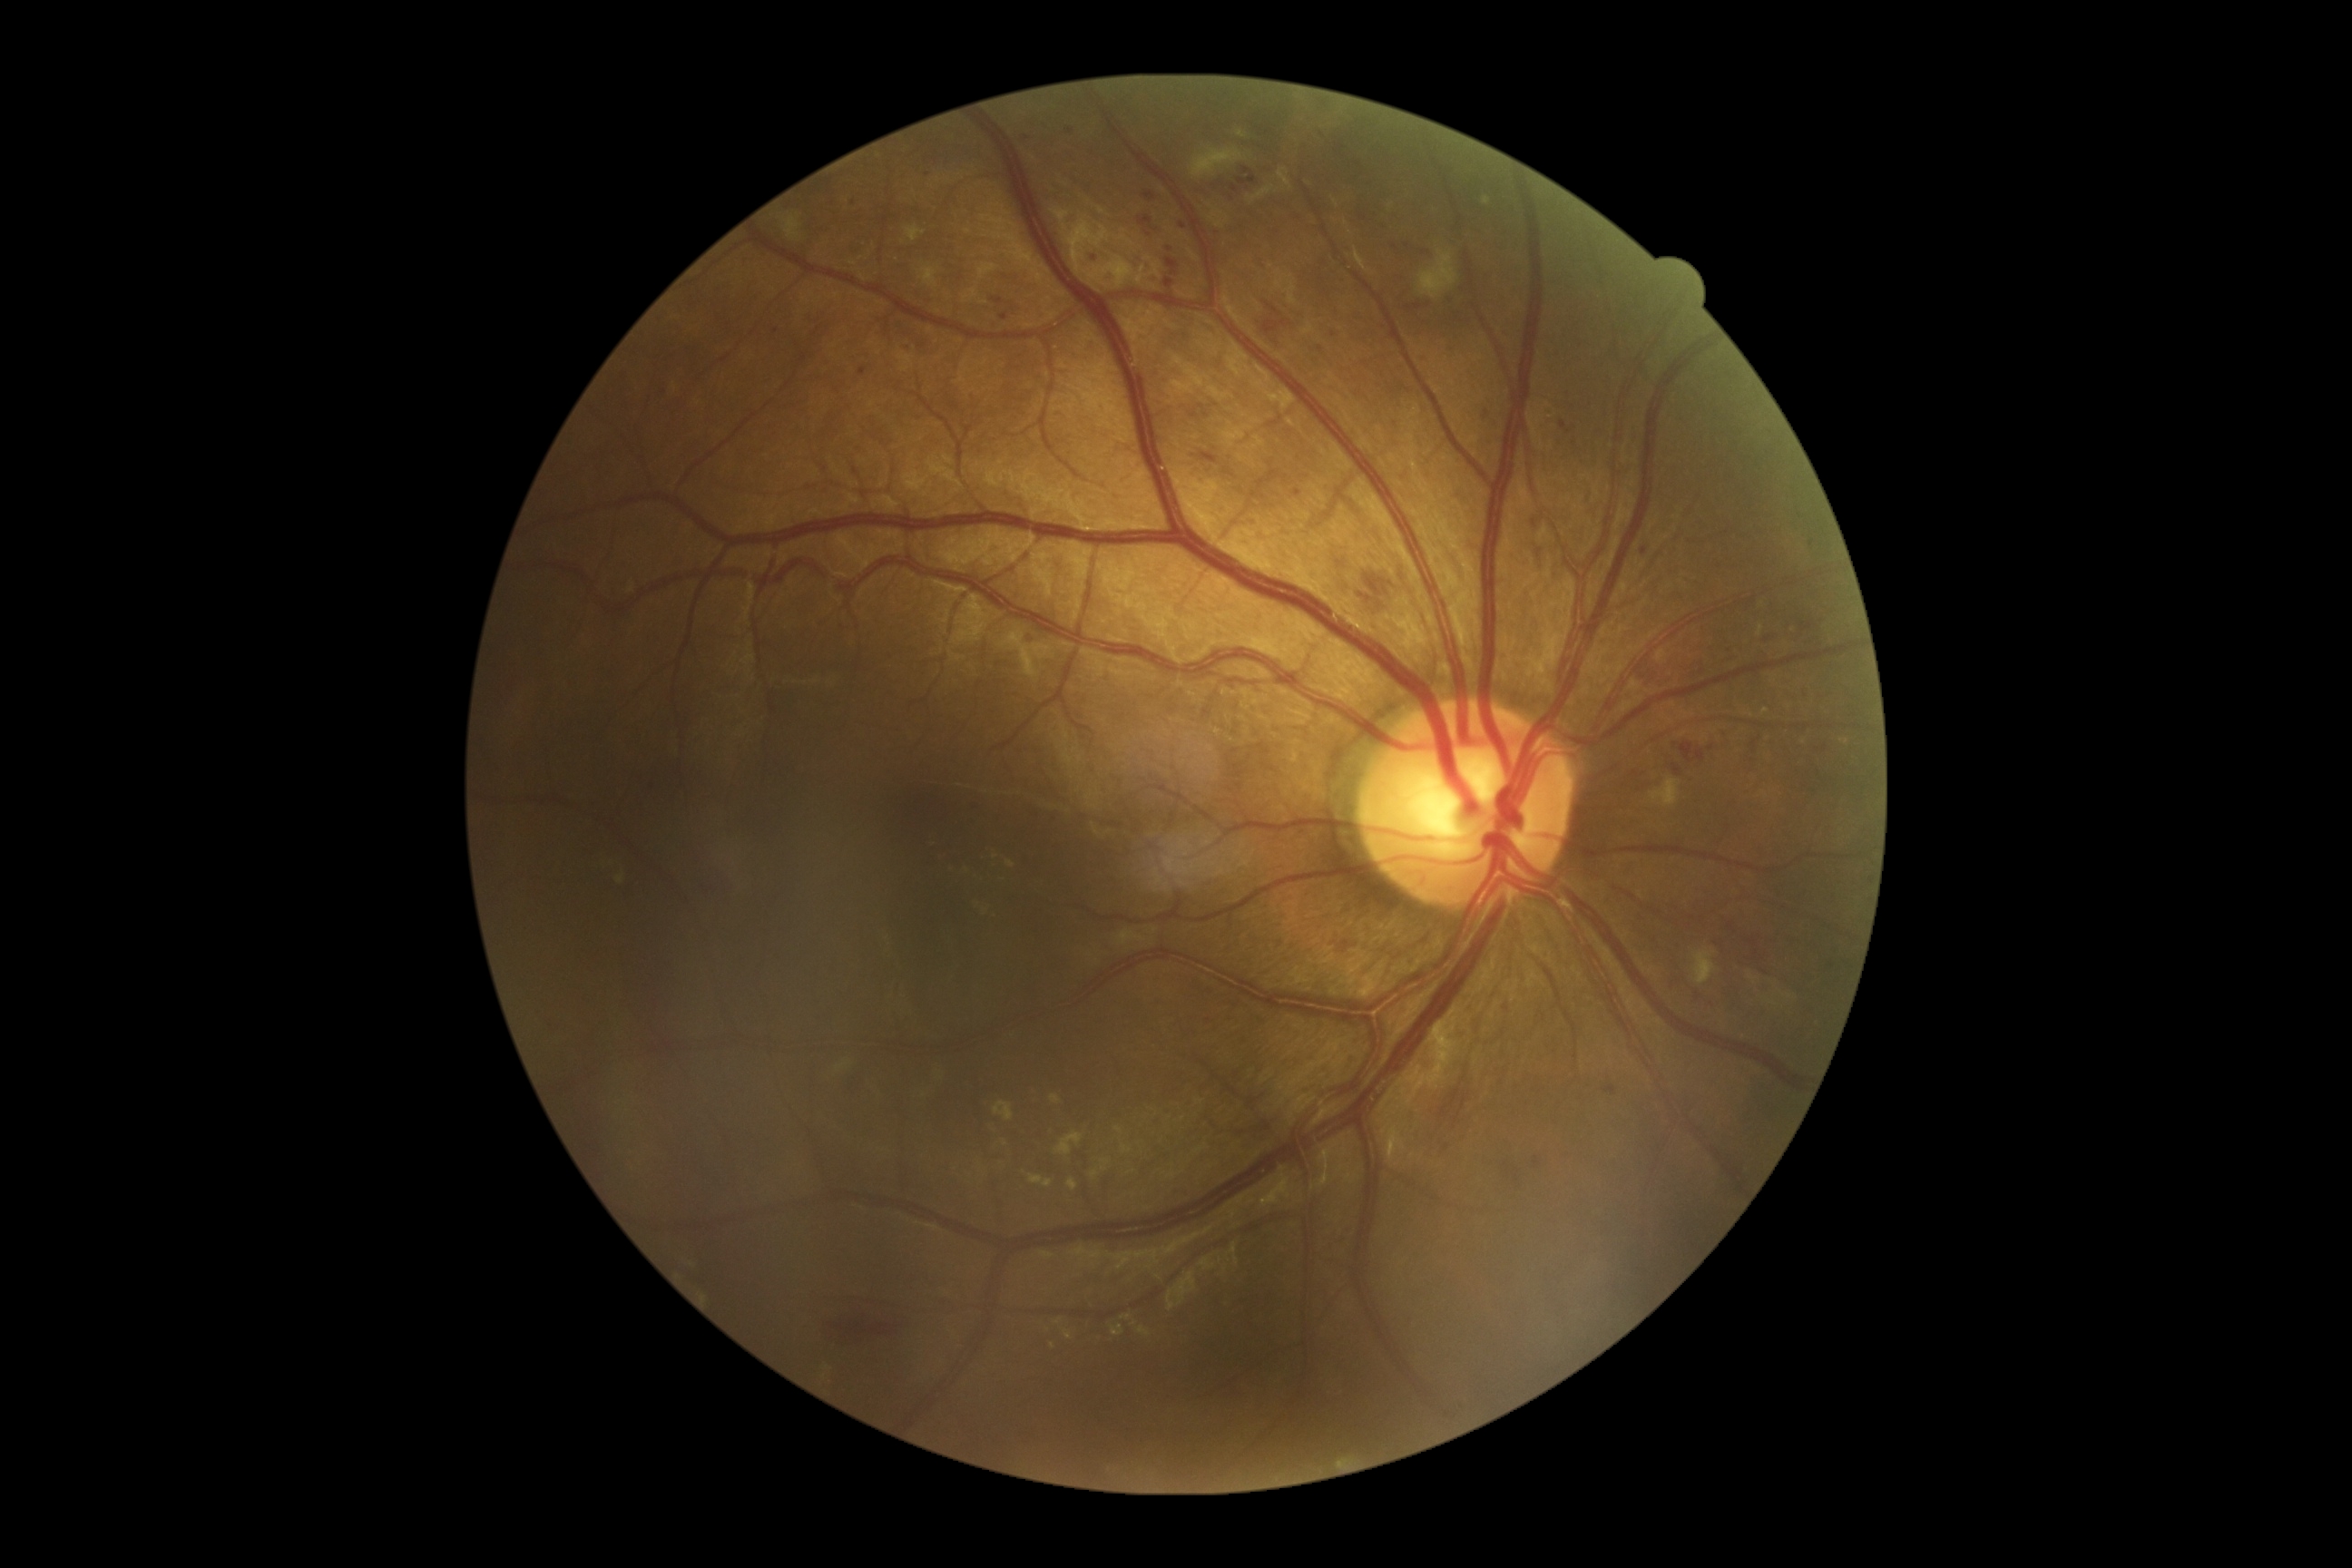 DR severity: moderate NPDR (grade 2) — more than just microaneurysms but less than severe NPDR.
The retinopathy is classified as non-proliferative diabetic retinopathy.